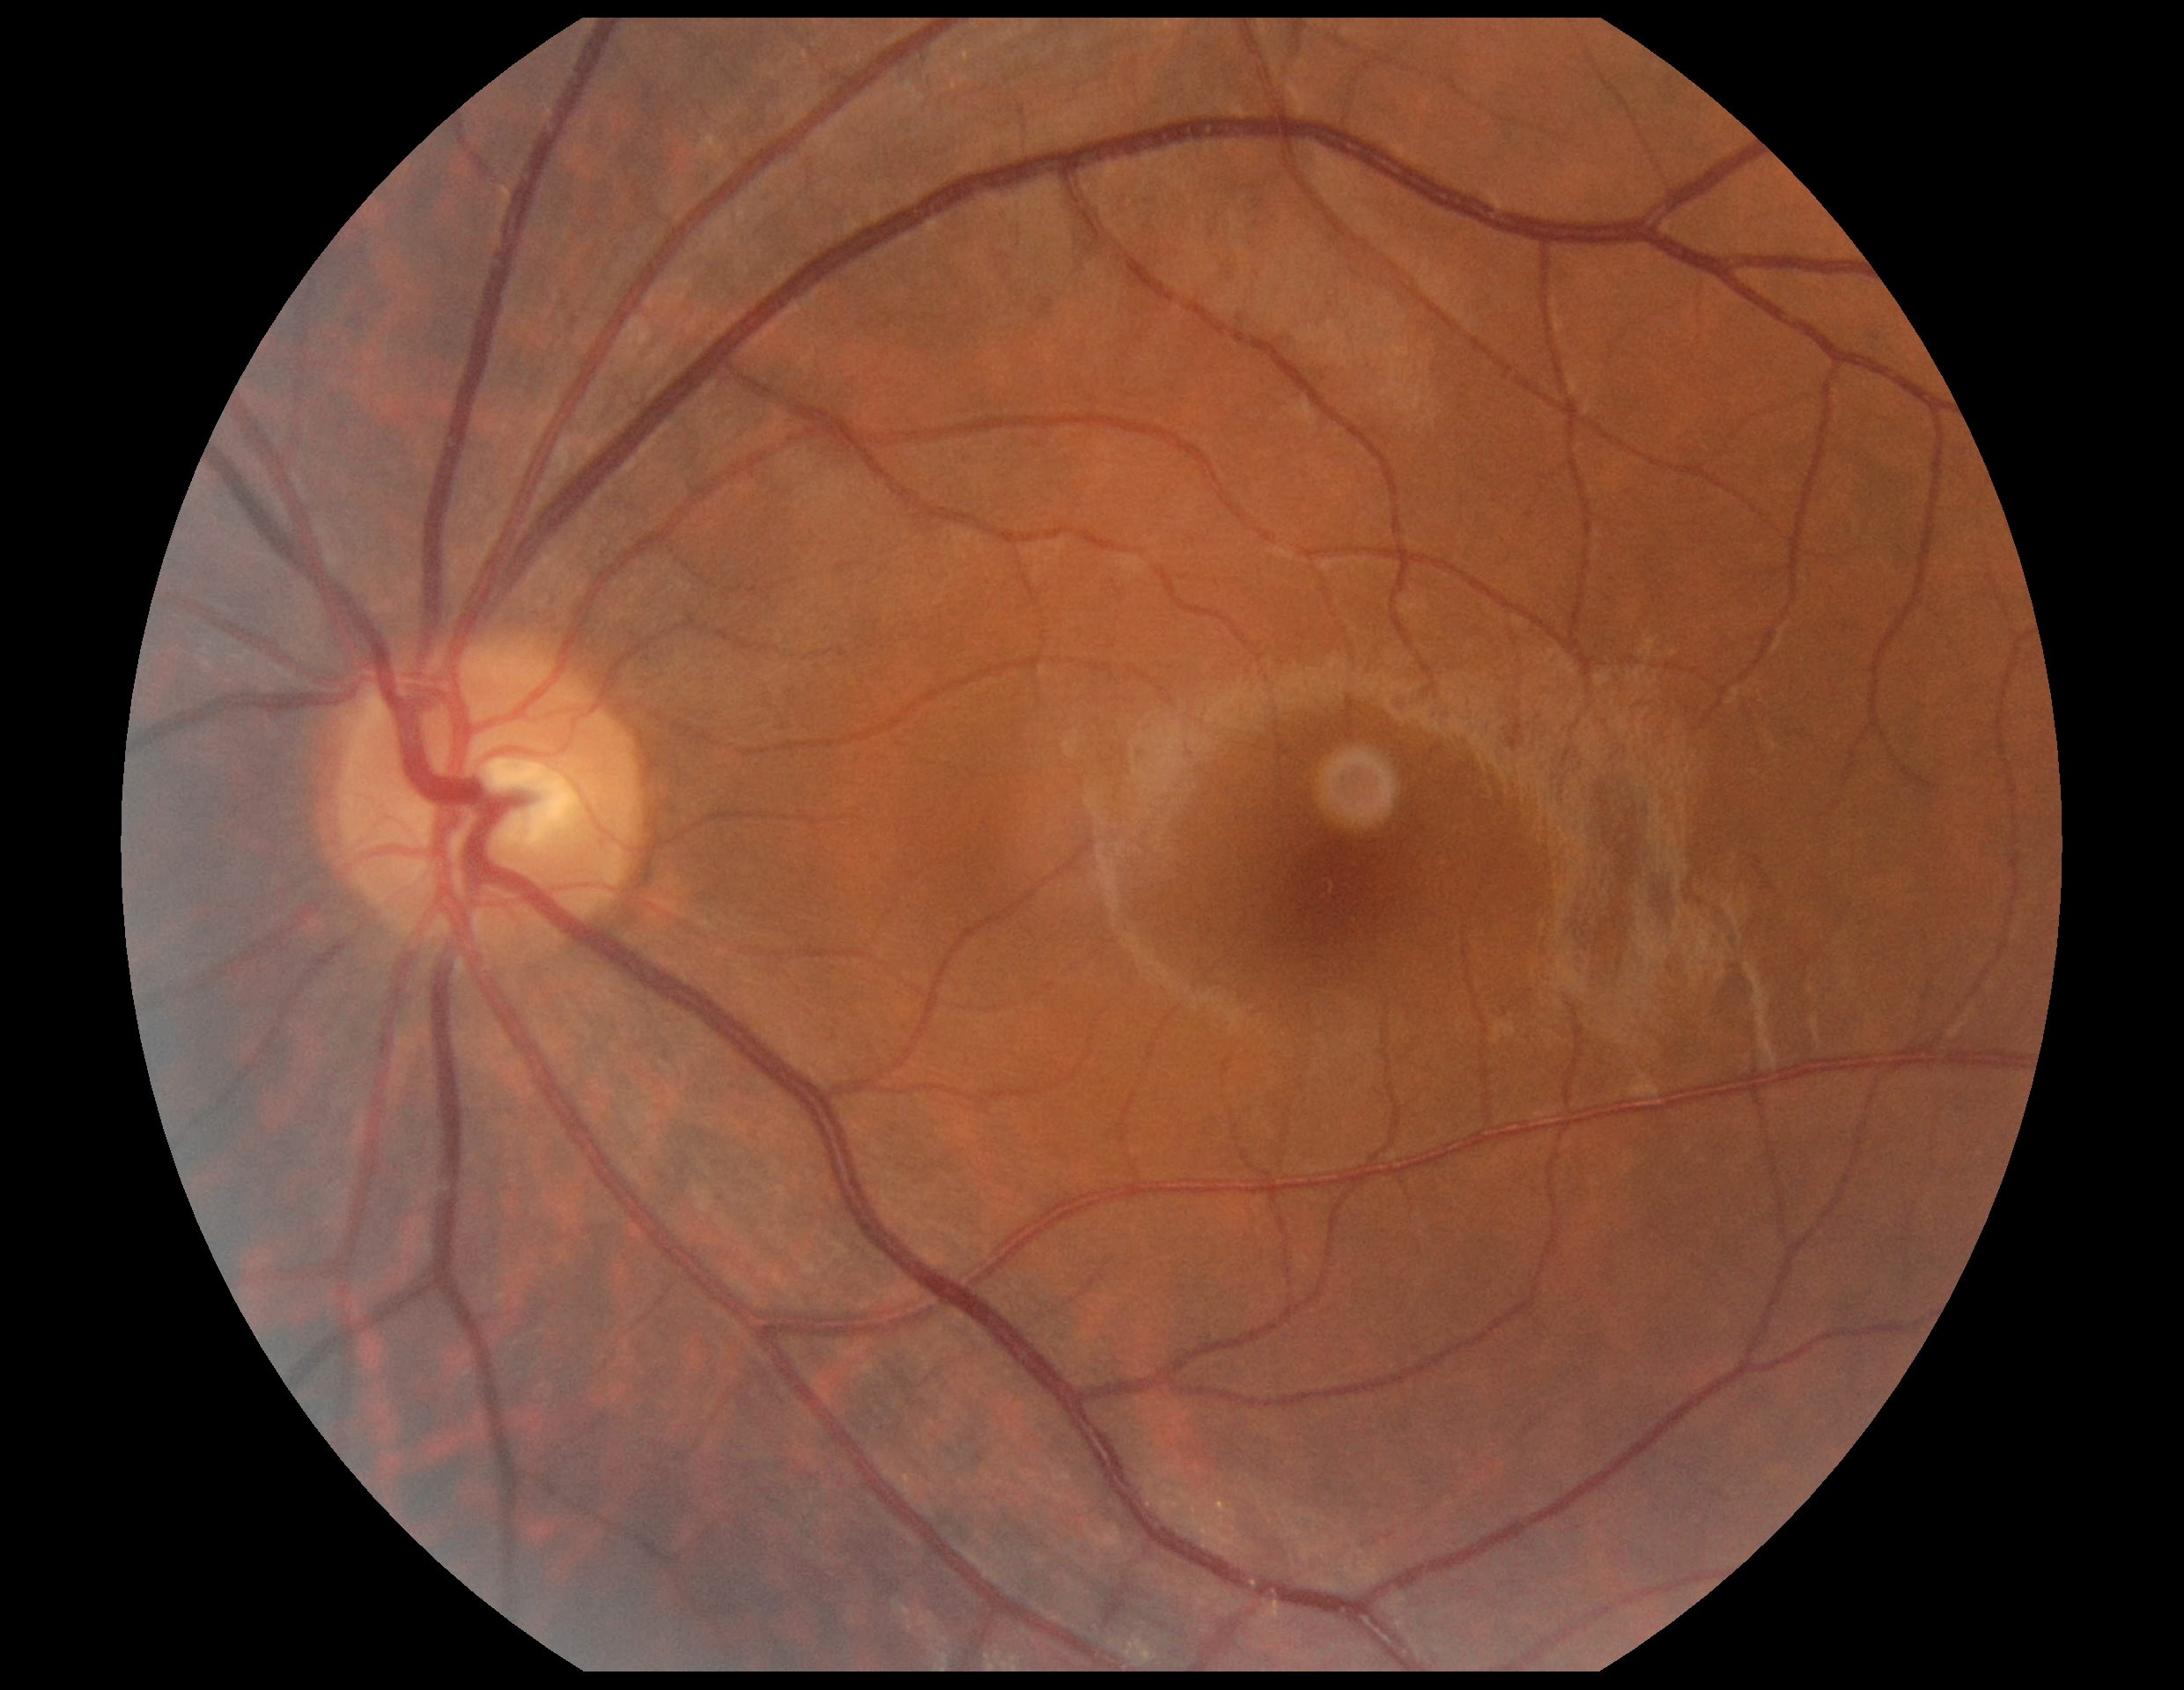

No apparent diabetic retinopathy.
Retinopathy grade is no apparent diabetic retinopathy (0) — no visible signs of diabetic retinopathy.